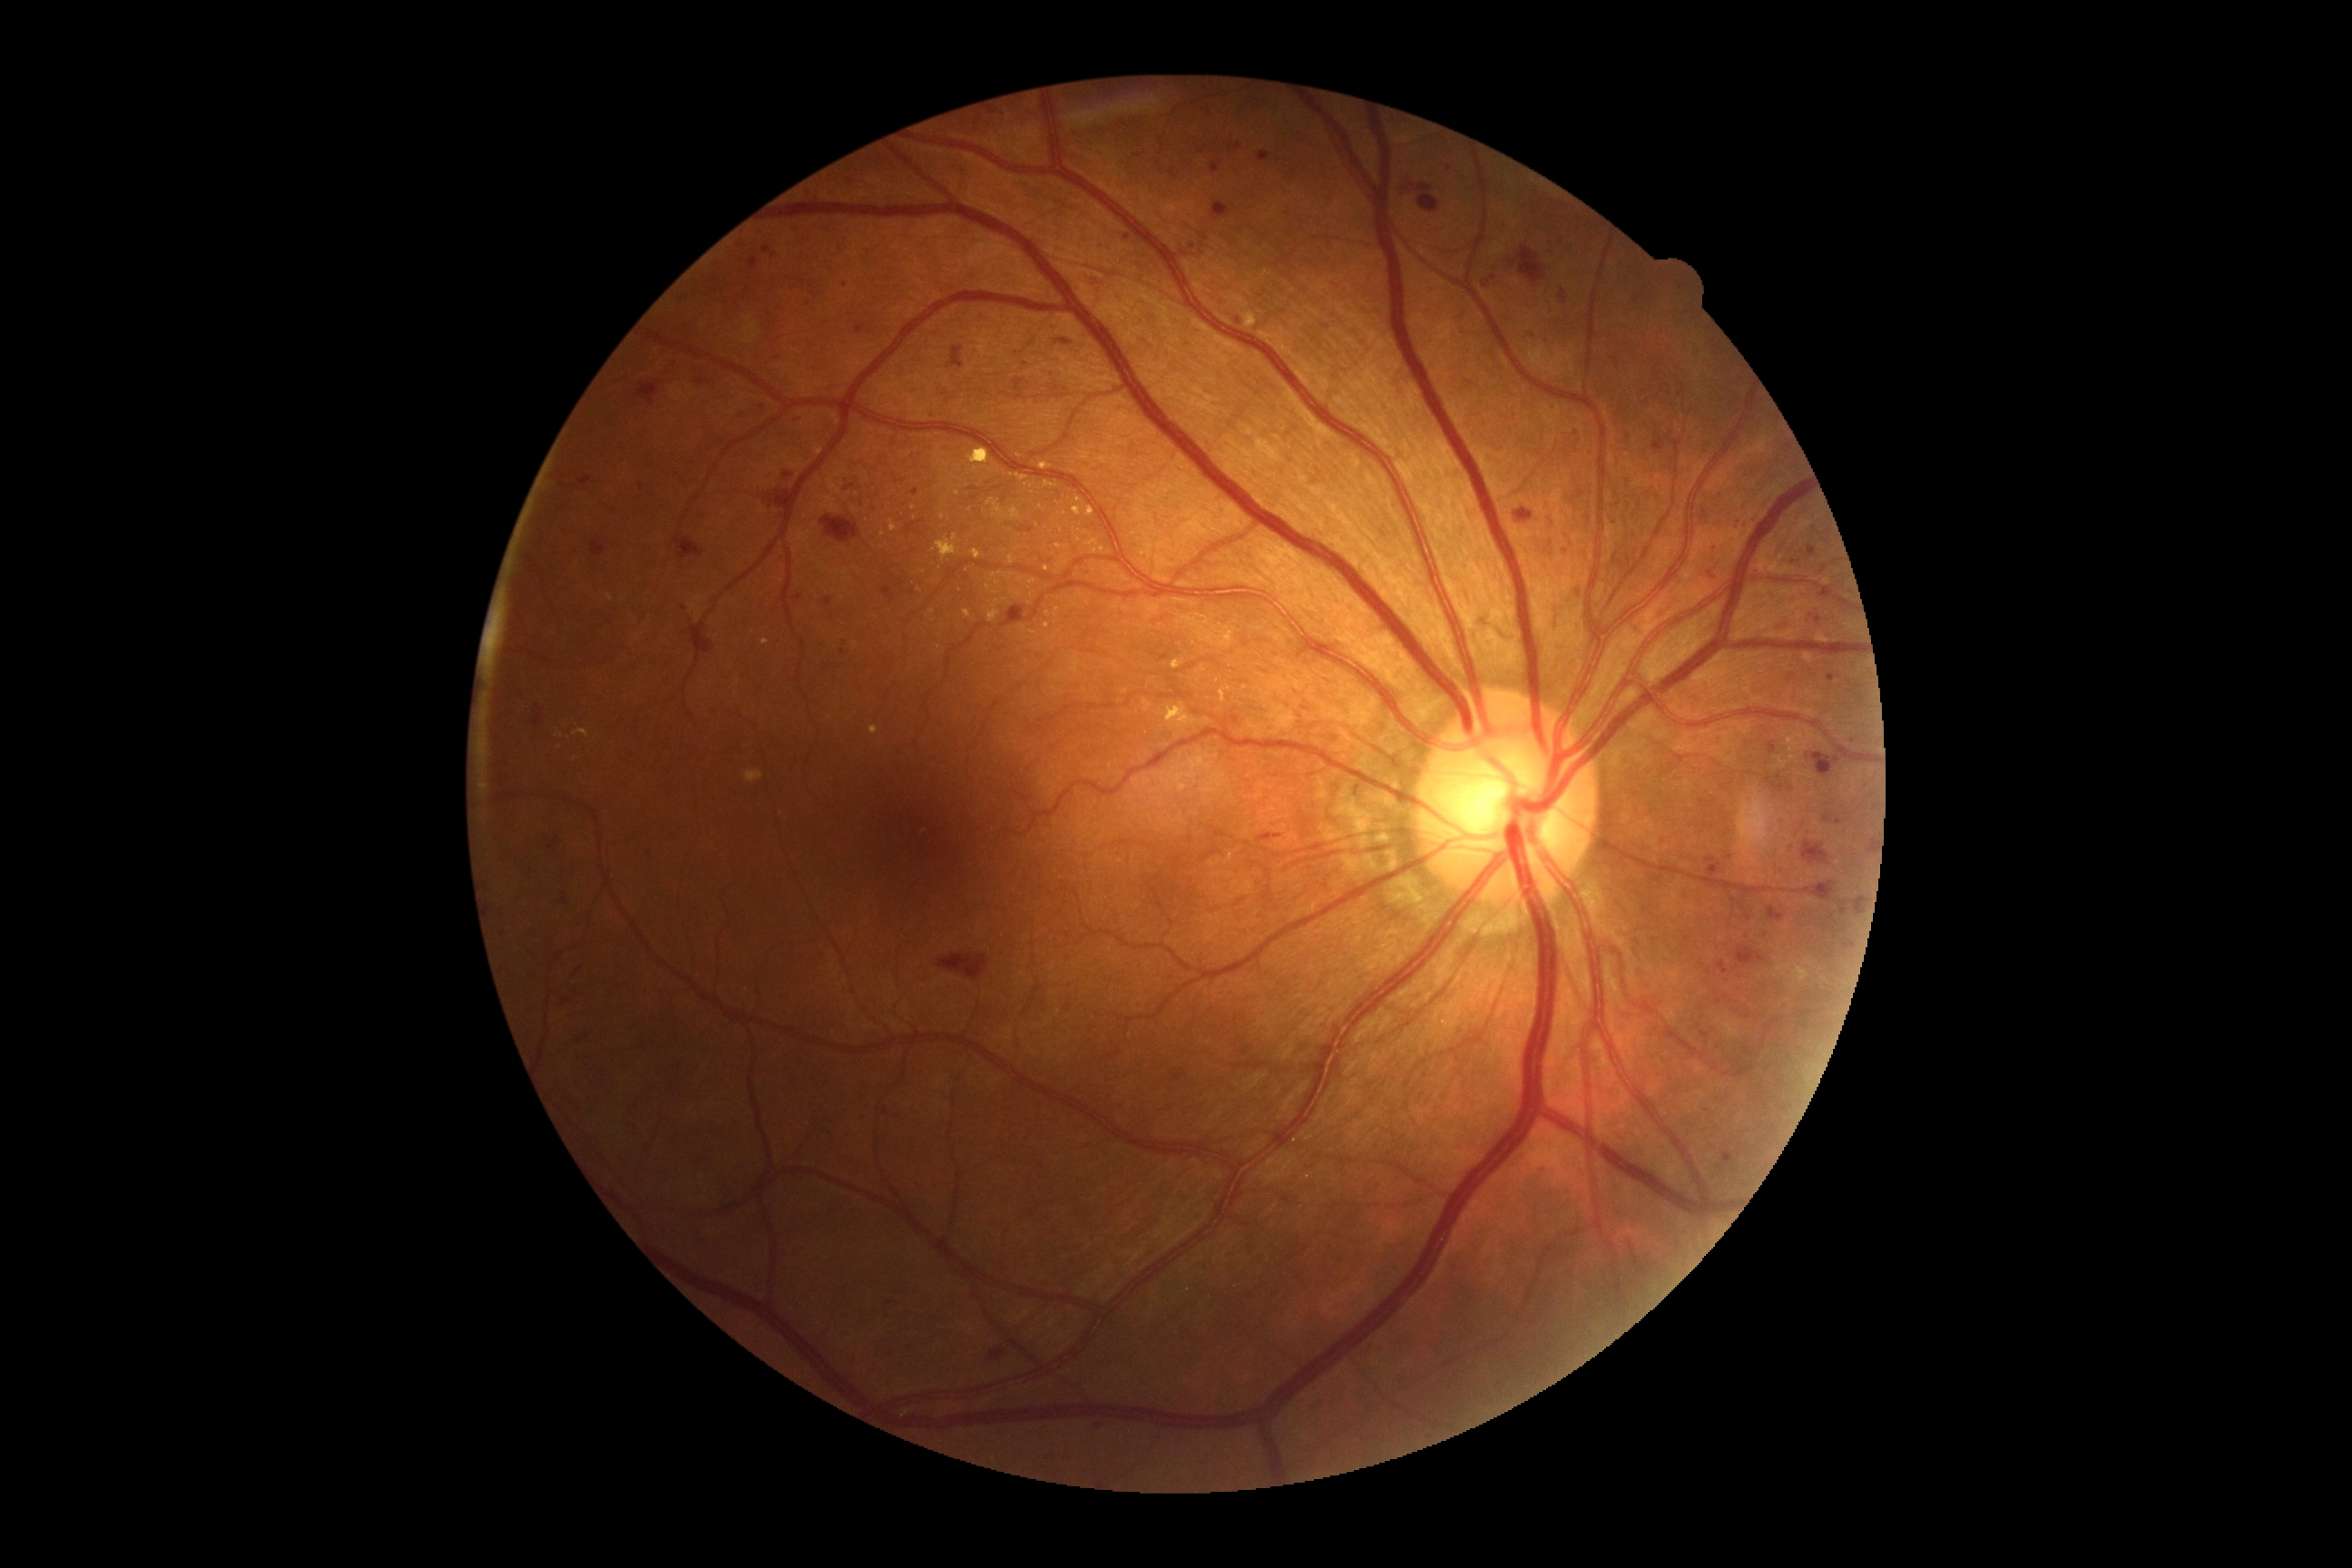 Retinopathy grade: moderate NPDR (2); non-proliferative diabetic retinopathy
A subset of detected lesions:
microaneurysms (subset): <box>549,838,560,848</box>; <box>1707,858,1723,877</box>; <box>1482,275,1496,288</box>; <box>1808,547,1816,556</box>; <box>794,594,803,600</box>; <box>1197,150,1206,153</box>; <box>783,473,794,480</box>; <box>1021,527,1035,534</box>; <box>1654,438,1665,453</box>
Small microaneurysms approximately at <pt>1173,172</pt>; <pt>1532,335</pt>; <pt>641,487</pt>; <pt>1687,940</pt>; <pt>1183,254</pt>; <pt>844,653</pt>; <pt>1854,741</pt>; <pt>684,298</pt>; <pt>1716,548</pt>
soft exudates: none
hard exudates (subset): <box>1778,965,1808,985</box>; <box>968,449,990,464</box>; <box>1166,703,1197,730</box>; <box>1044,565,1050,573</box>; <box>988,605,1001,623</box>; <box>990,573,1004,582</box>; <box>1039,464,1052,471</box>; <box>1086,507,1095,516</box>; <box>1220,687,1231,703</box>; <box>870,727,877,736</box>; <box>1244,313,1257,329</box>; <box>1008,554,1014,565</box>; <box>1073,507,1084,516</box>
Small hard exudates approximately at <pt>561,748</pt>; <pt>997,583</pt>; <pt>958,493</pt>; <pt>943,517</pt>; <pt>766,642</pt>
hemorrhages (subset): <box>1411,184,1440,213</box>; <box>1006,605,1030,620</box>; <box>937,954,990,981</box>; <box>1723,1152,1734,1164</box>; <box>1810,881,1836,901</box>; <box>1823,810,1843,825</box>; <box>1807,747,1843,778</box>; <box>674,534,703,560</box>; <box>856,482,876,511</box>; <box>534,718,540,727</box>; <box>1213,202,1230,220</box>; <box>1257,834,1282,843</box>; <box>821,516,861,544</box>